FOV: 45 degrees. Nonmydriatic — 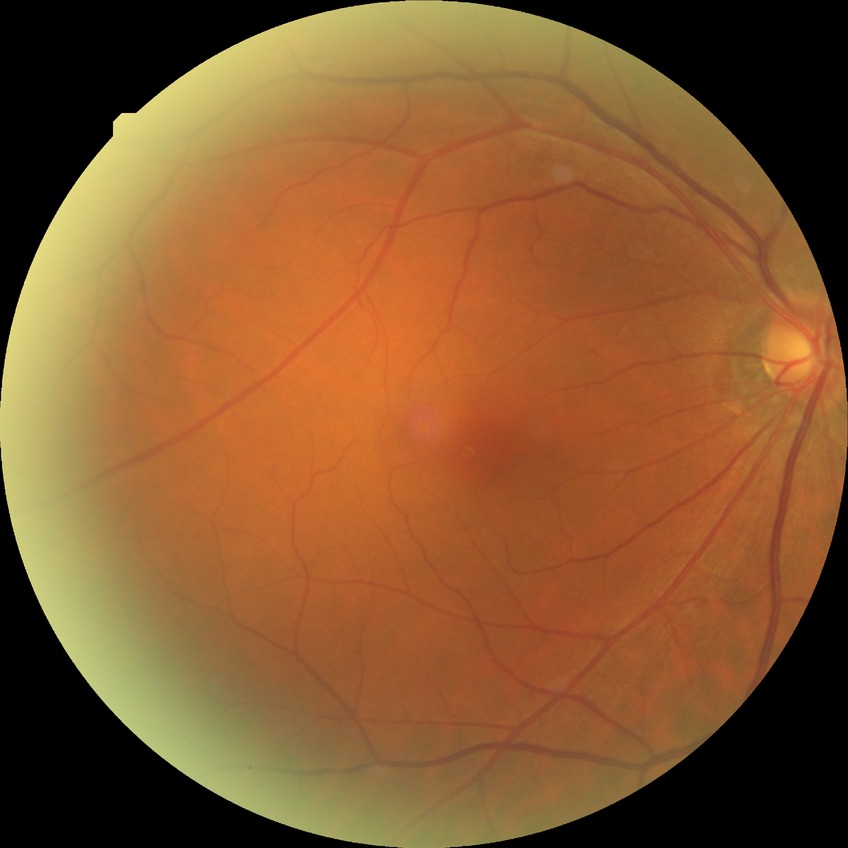 Diabetic retinopathy severity: no diabetic retinopathy.